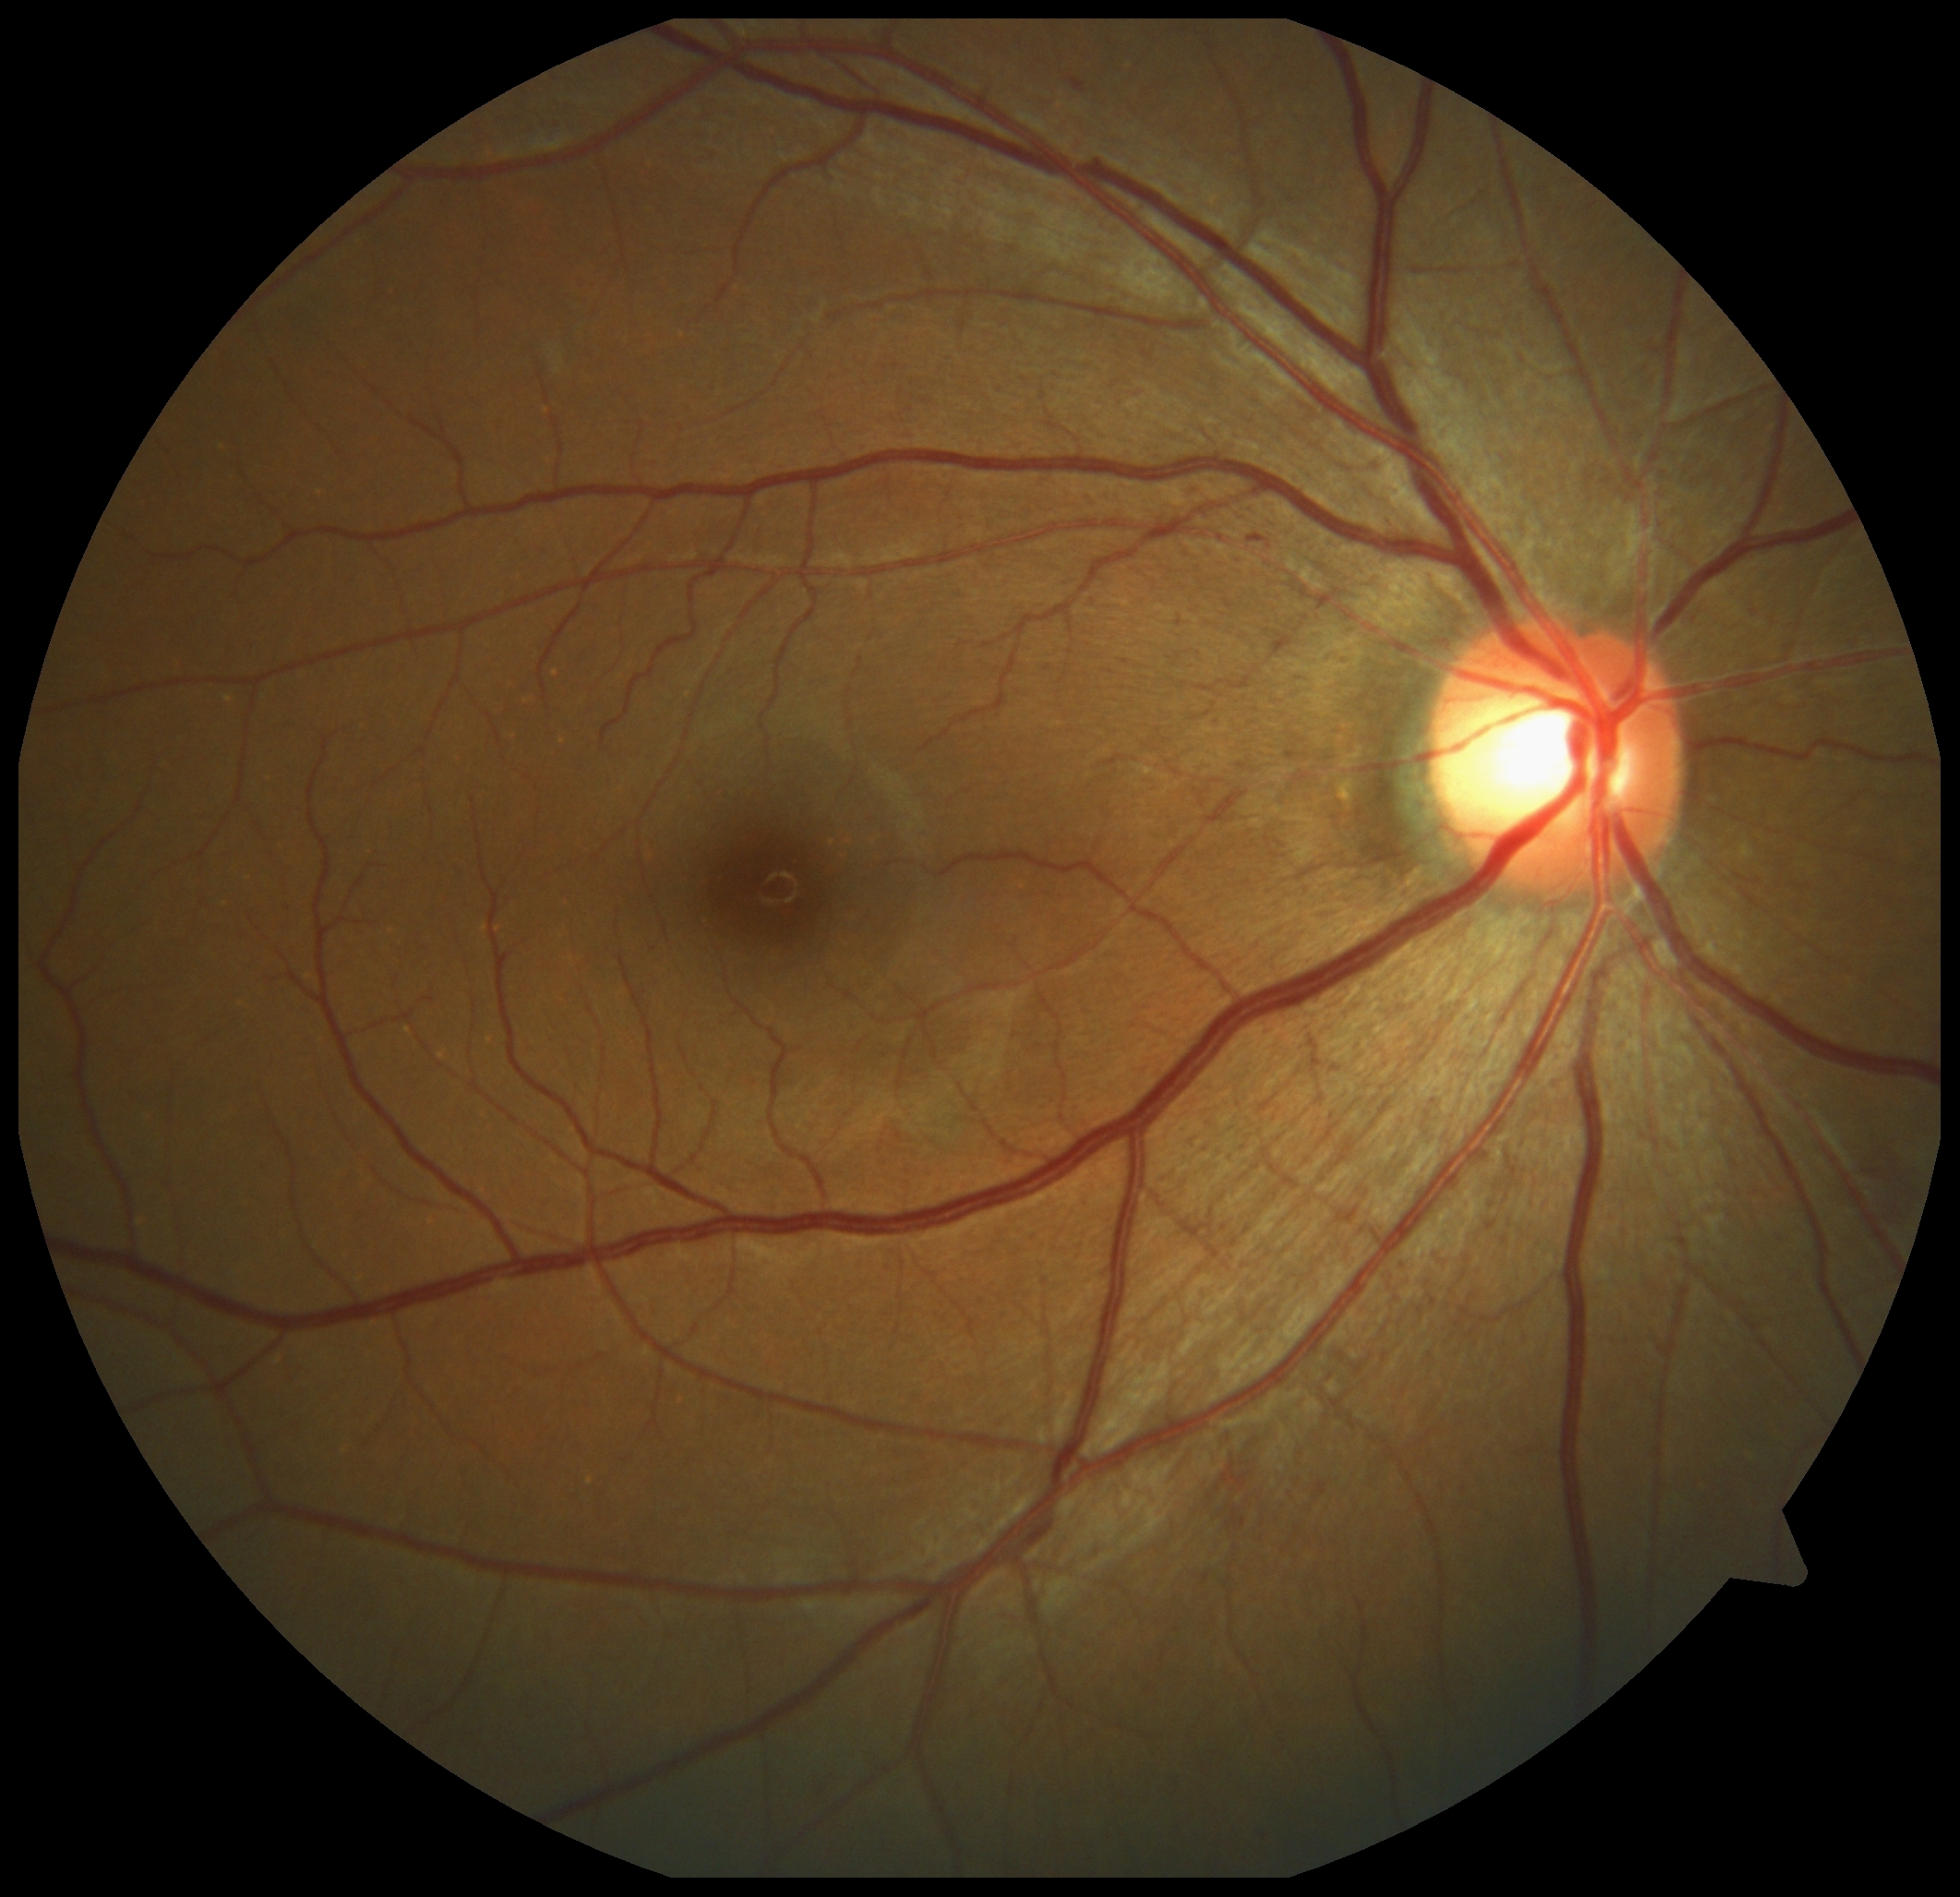
DR severity=1, DR class=non-proliferative diabetic retinopathy.